FOV: 45 degrees:
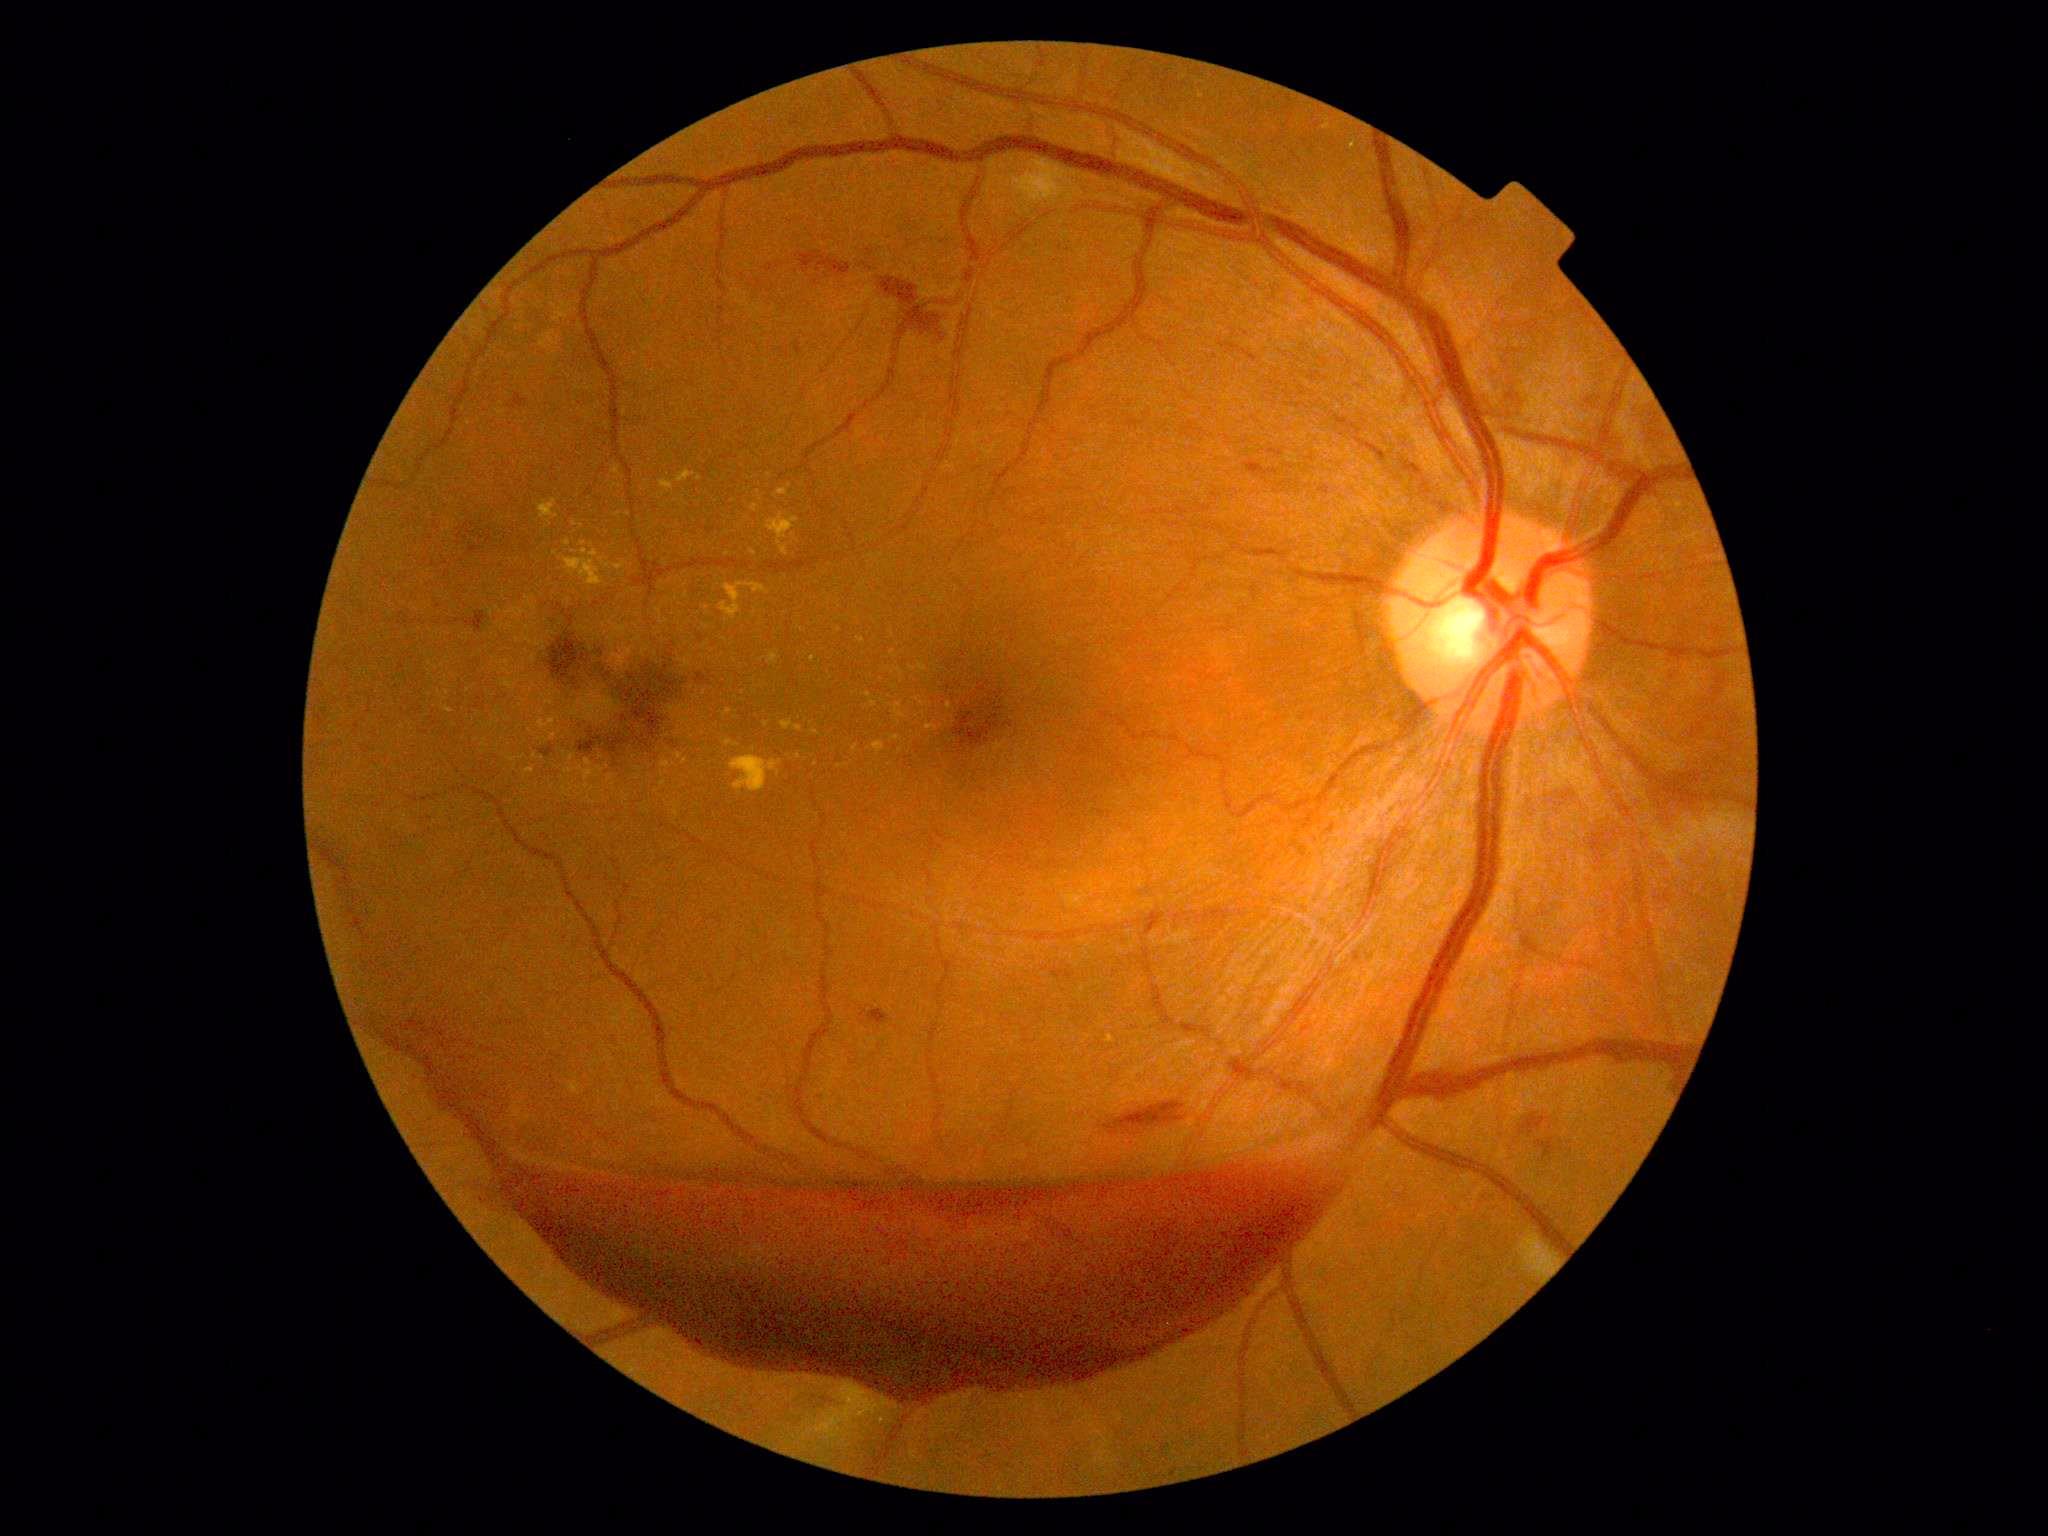 DR is proliferative diabetic retinopathy (grade 4)
Representative lesions:
EXs (continued): 578/759/605/782; 525/768/535/775; 586/784/596/805; 659/481/674/492; 891/735/902/742; 926/724/939/732; 565/769/575/774
Small EXs near [700,479]; [627,799]; [940,782]; [770,475]; [743,693]; [543,759]; [728,554]; [505,664]; [656,792]; [924,704]